45° field of view
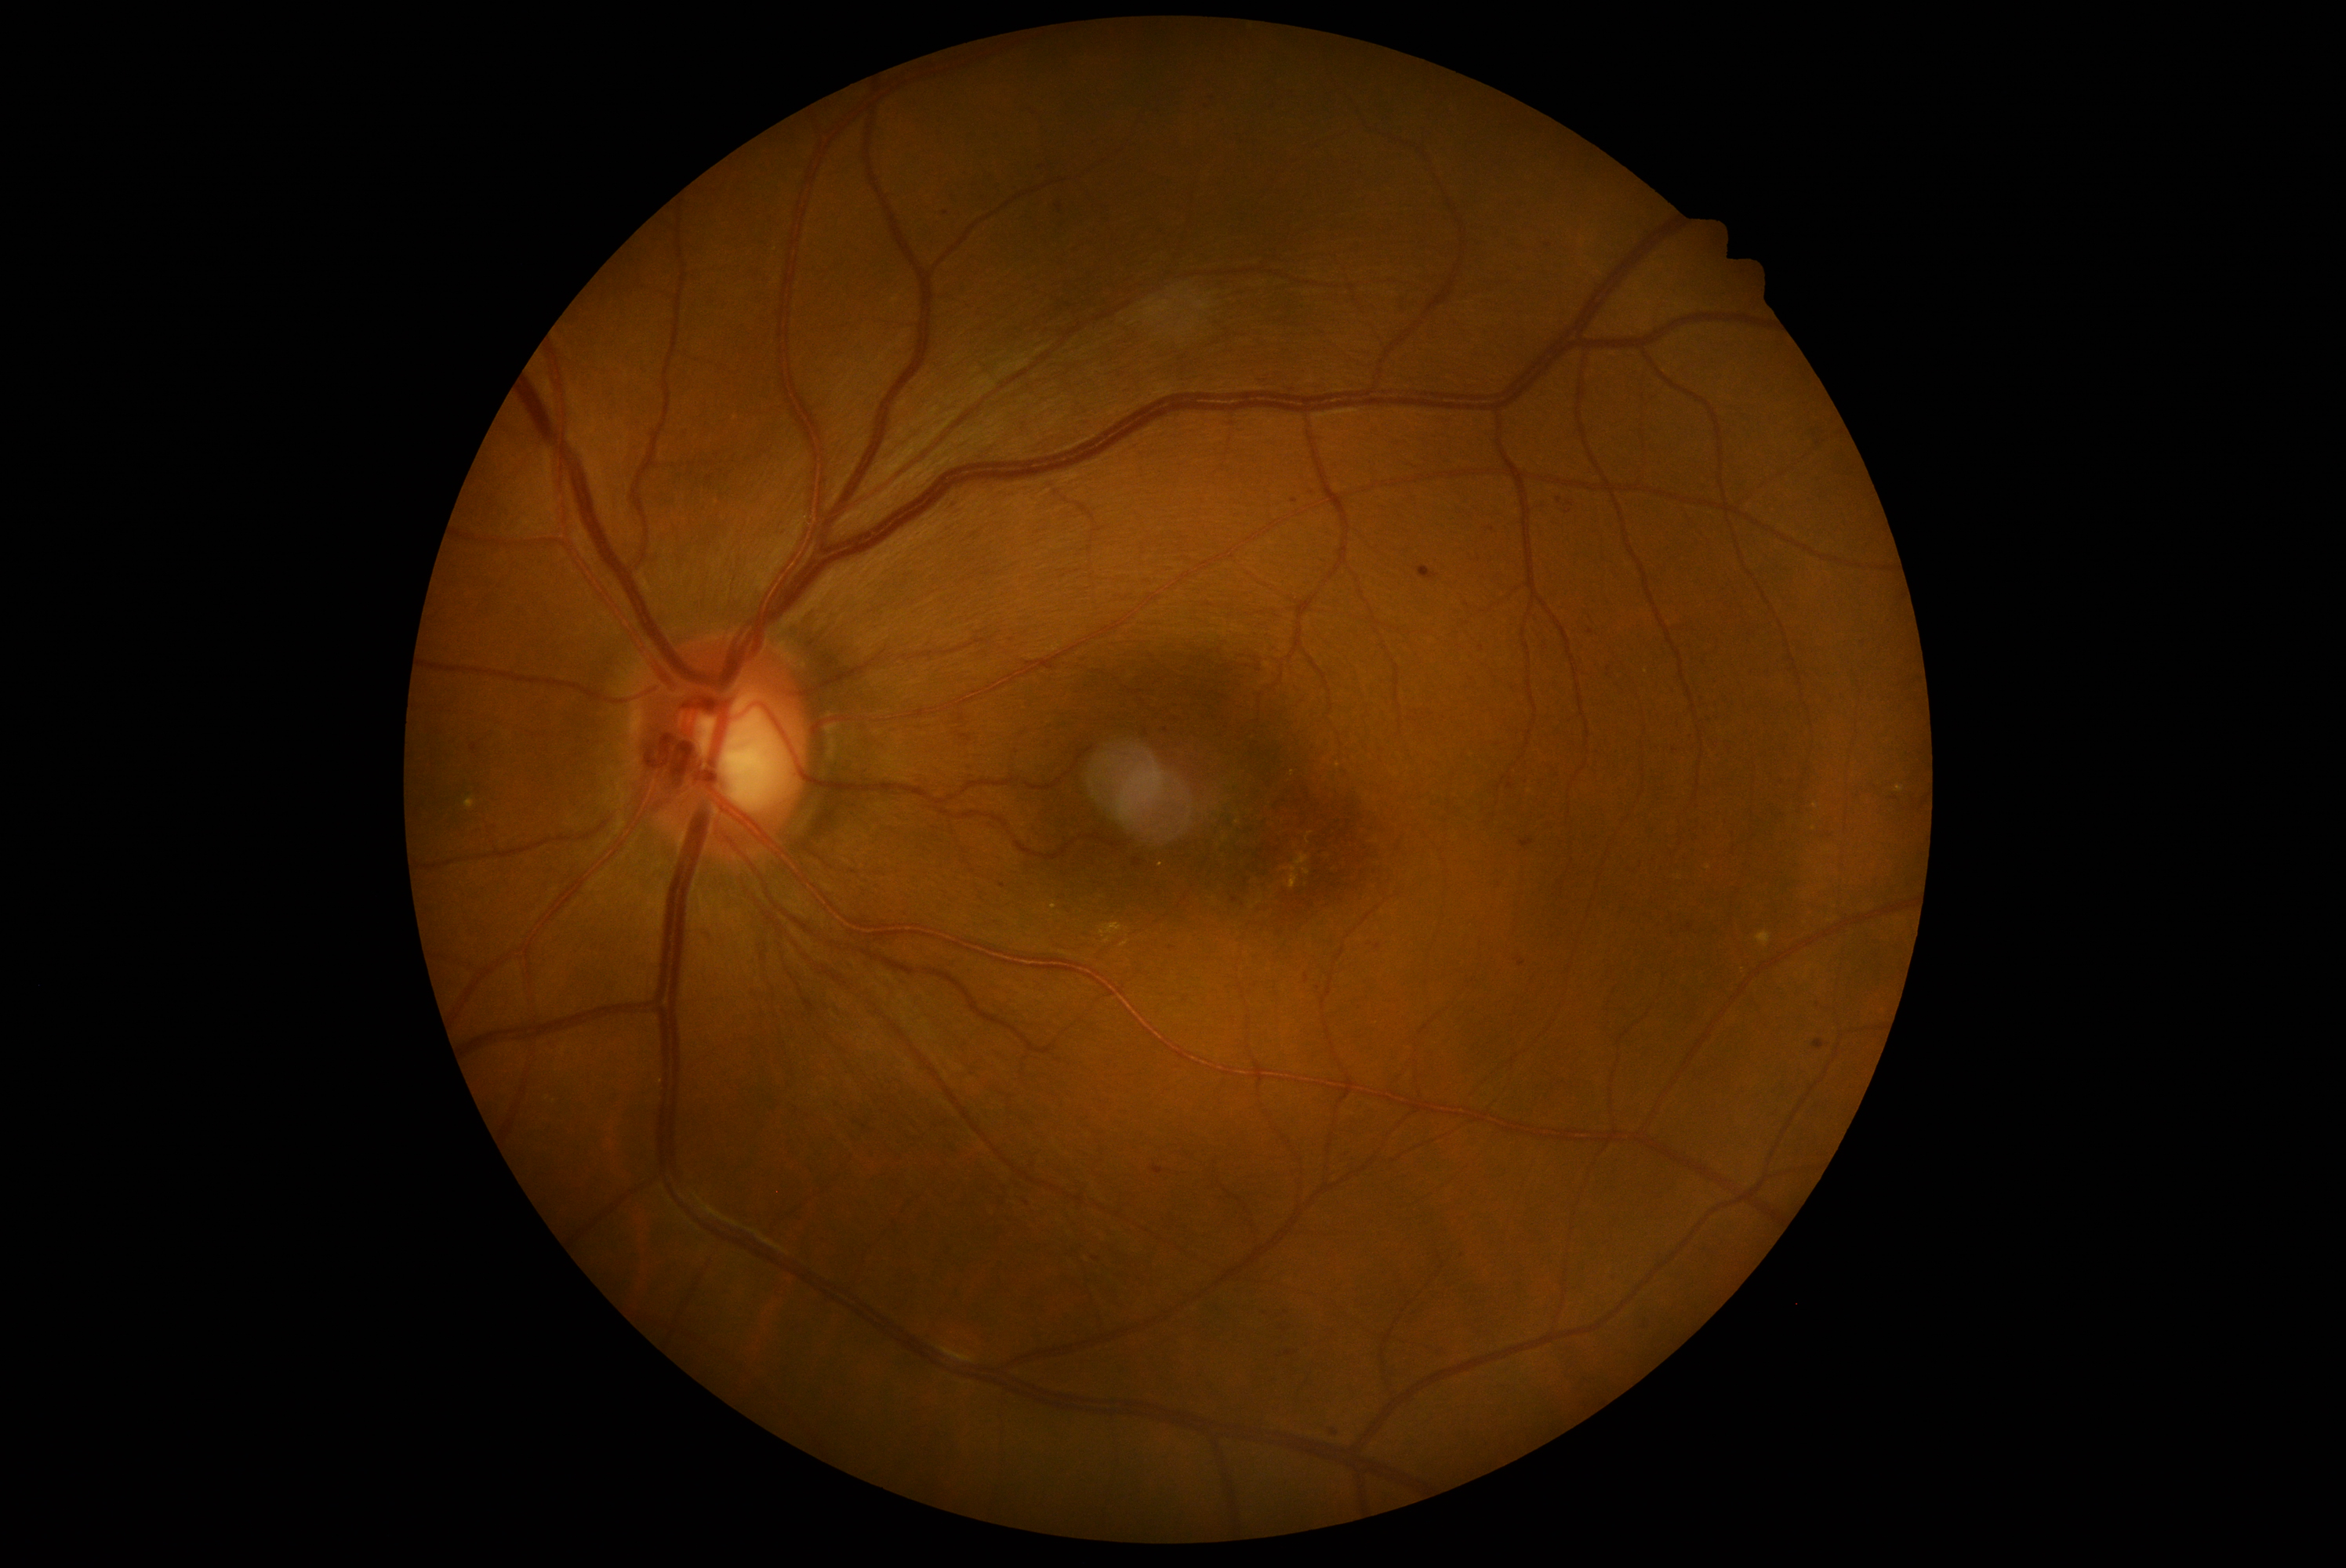
Diabetic retinopathy (DR): grade 2 (moderate NPDR)
A subset of detected lesions:
microaneurysms (MAs) (partial): 1423:568:1431:578; 1153:1167:1164:1175; 1291:499:1299:504; 1516:957:1527:967
Small MAs approximately at (1674; 750); (1482; 649); (1166; 731); (945; 214); (1235; 901); (1818; 1005); (1378; 948); (1266; 1311); (1570; 505); (1492; 530); (1559; 500); (1172; 948); (1318; 988)
soft exudates (SEs): none identified
hard exudates (EXs): 1113:924:1117:934; 1291:877:1295:890; 1120:942:1130:948; 465:799:476:810; 1895:785:1905:793; 1105:924:1111:934; 1757:932:1771:945
Small EXs approximately at (1161; 865); (1054; 908); (1293; 774); (1238; 822); (1816; 807); (1646; 672); (1814; 829); (1709; 868); (1337; 766)
hemorrhages (HEs): 1133:855:1146:869; 1520:840:1534:848
Small HEs approximately at (1060; 208)